640 by 480 pixels · pediatric wide-field fundus photograph · camera: Clarity RetCam 3 (130° FOV)
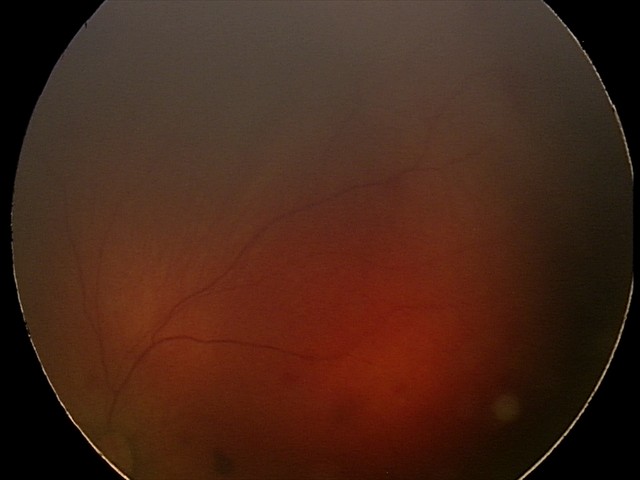
Q: What is the diagnosis from this examination?
A: retinal hemorrhages